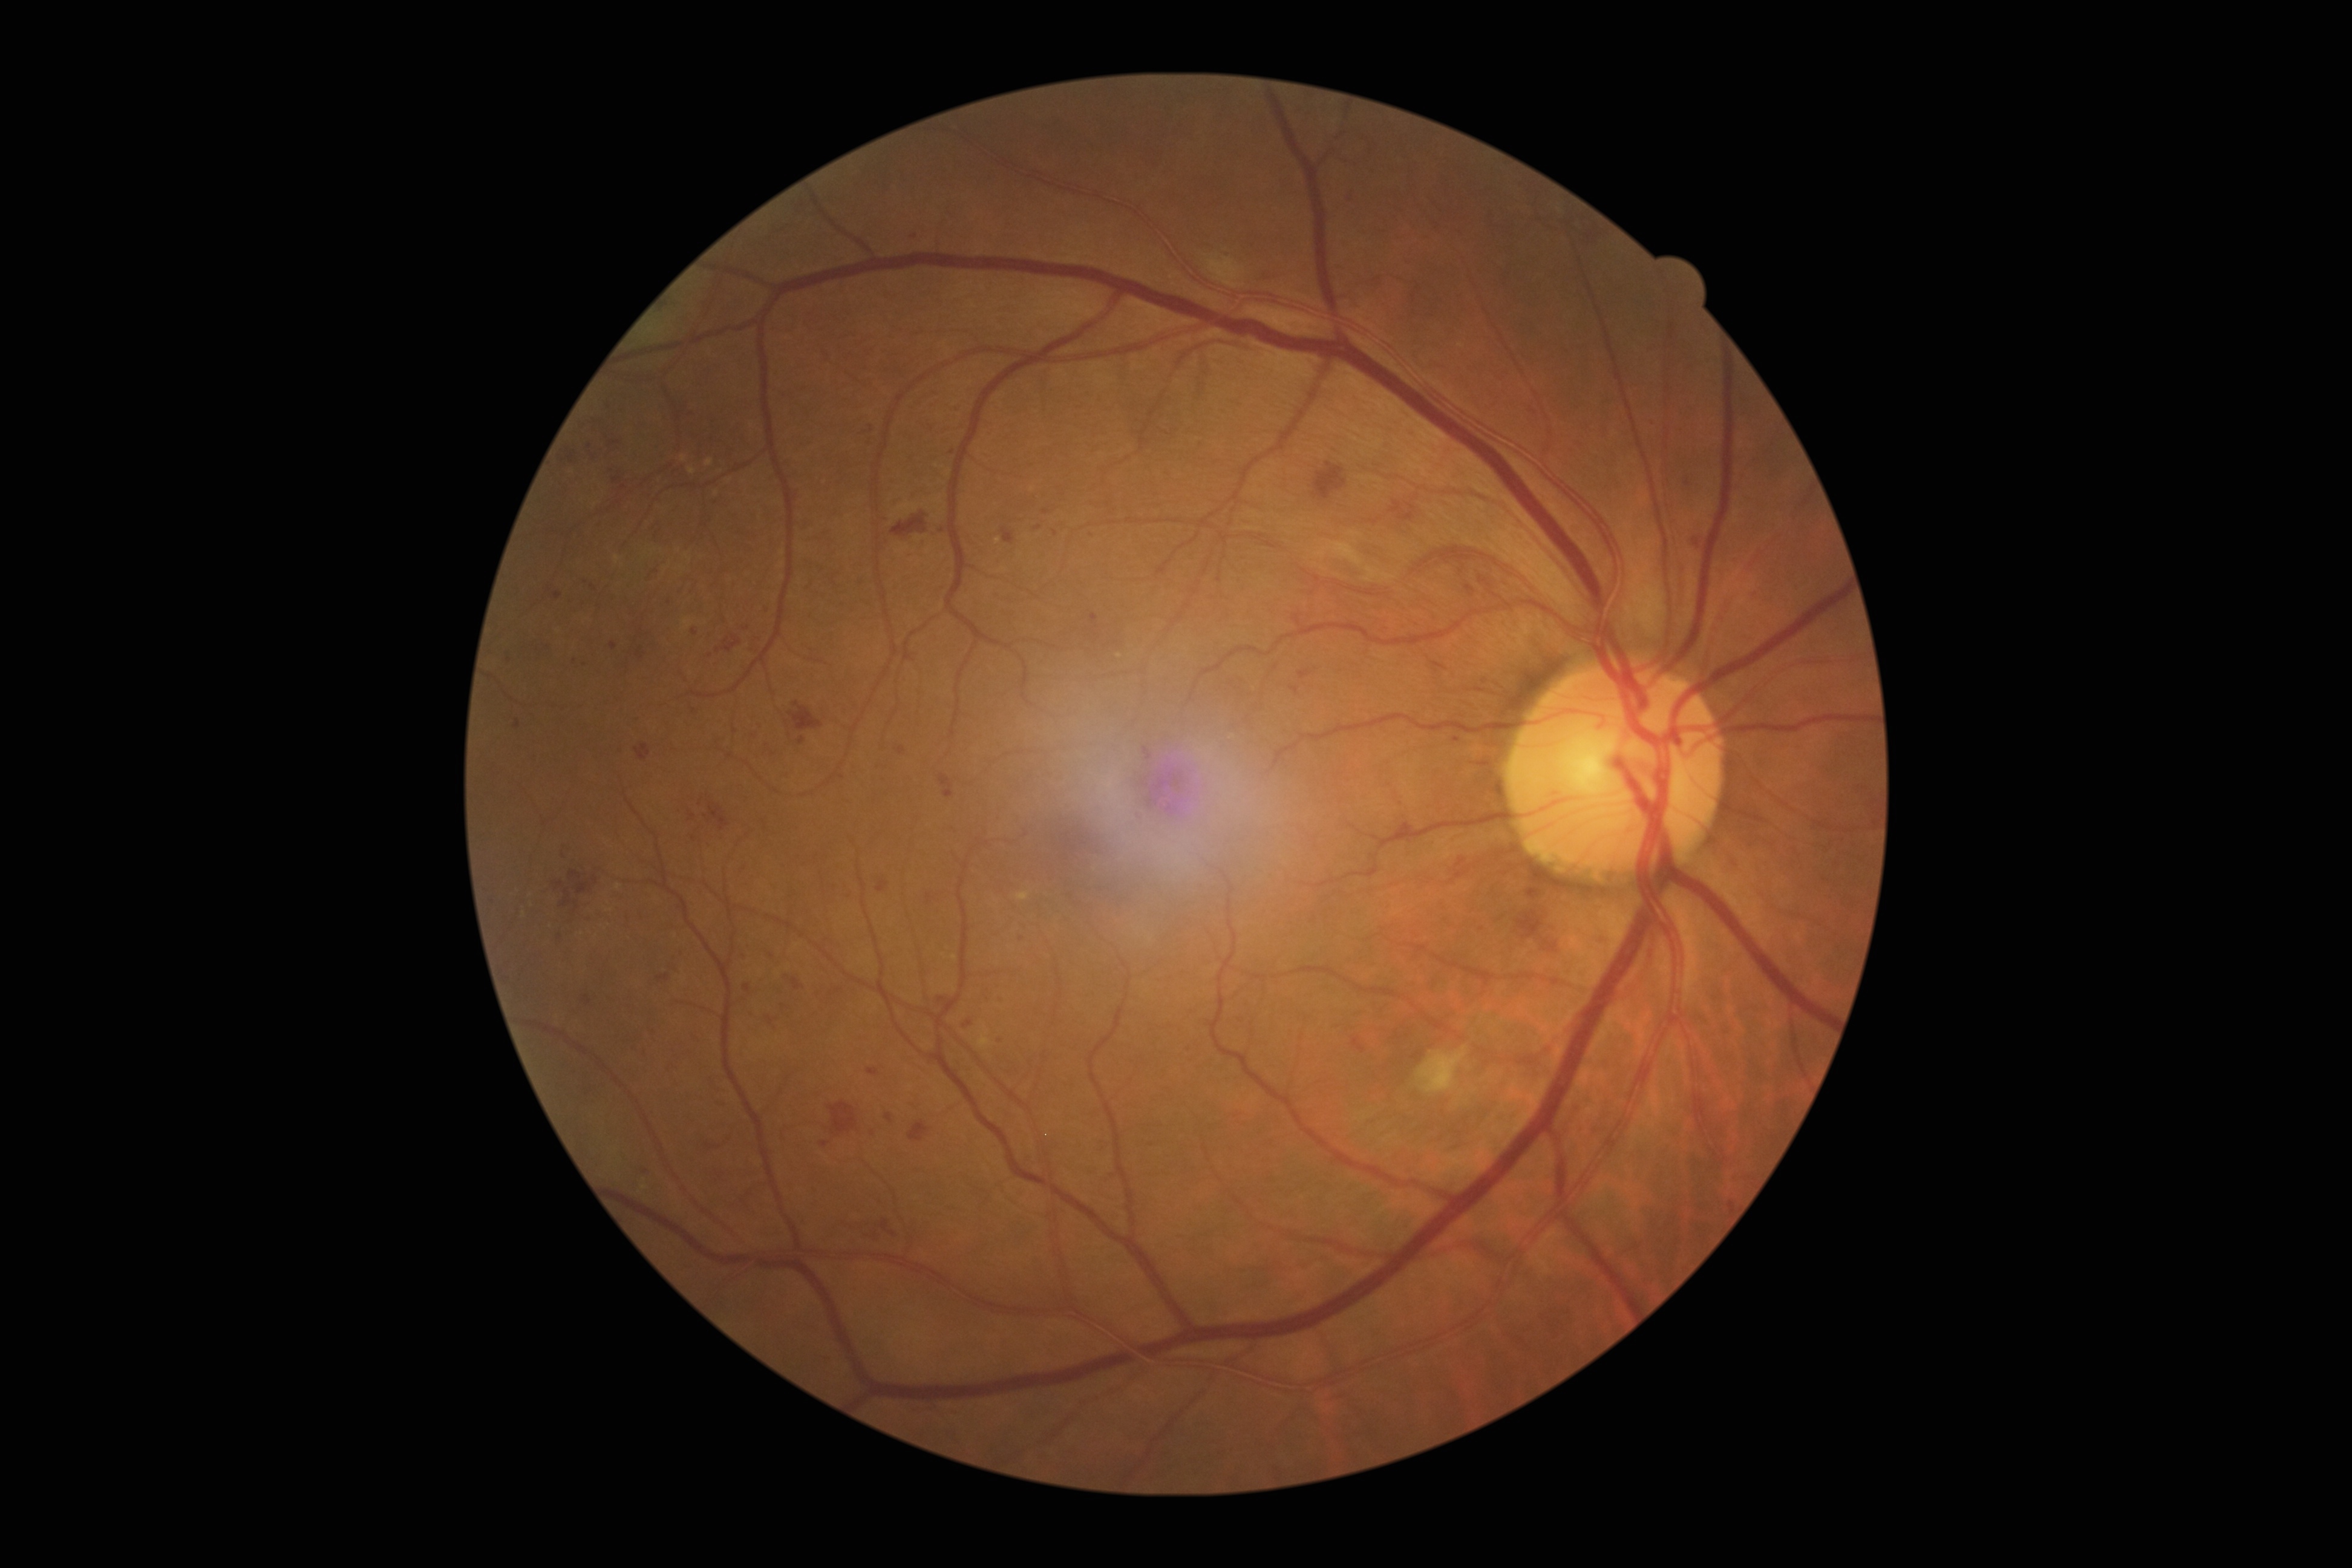
DR severity: 3/4 — more than 20 intraretinal hemorrhages in each of 4 quadrants, definite venous beading in 2 or more quadrants, or prominent intraretinal microvascular abnormalities in 1 or more quadrants, with no signs of proliferative retinopathy.